Phoenix ICON, 100° FOV; 1240x1240px; wide-field contact fundus photograph of an infant: 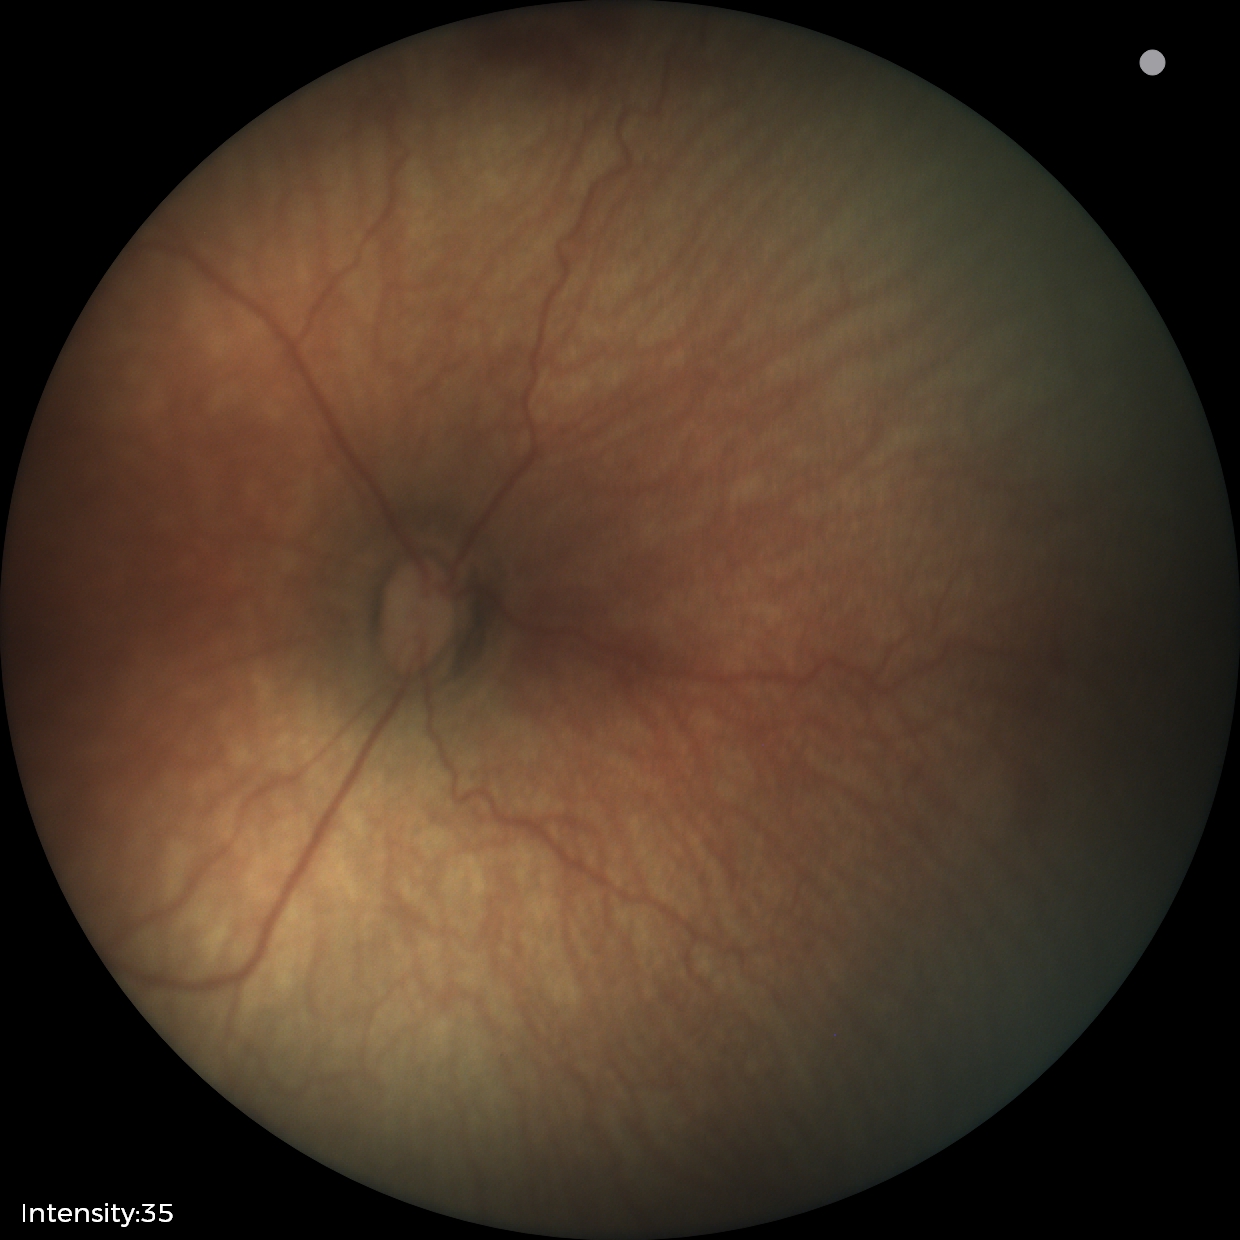
Assessment: retinopathy of prematurity stage 0 | no plus disease.